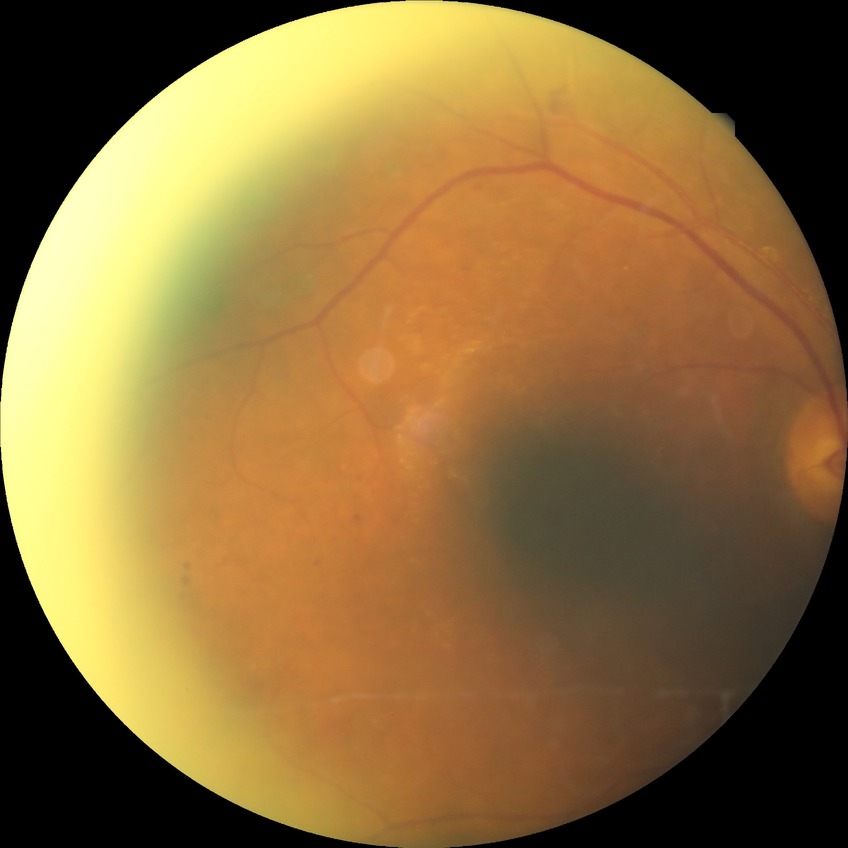 modified Davis grading=proliferative diabetic retinopathy.